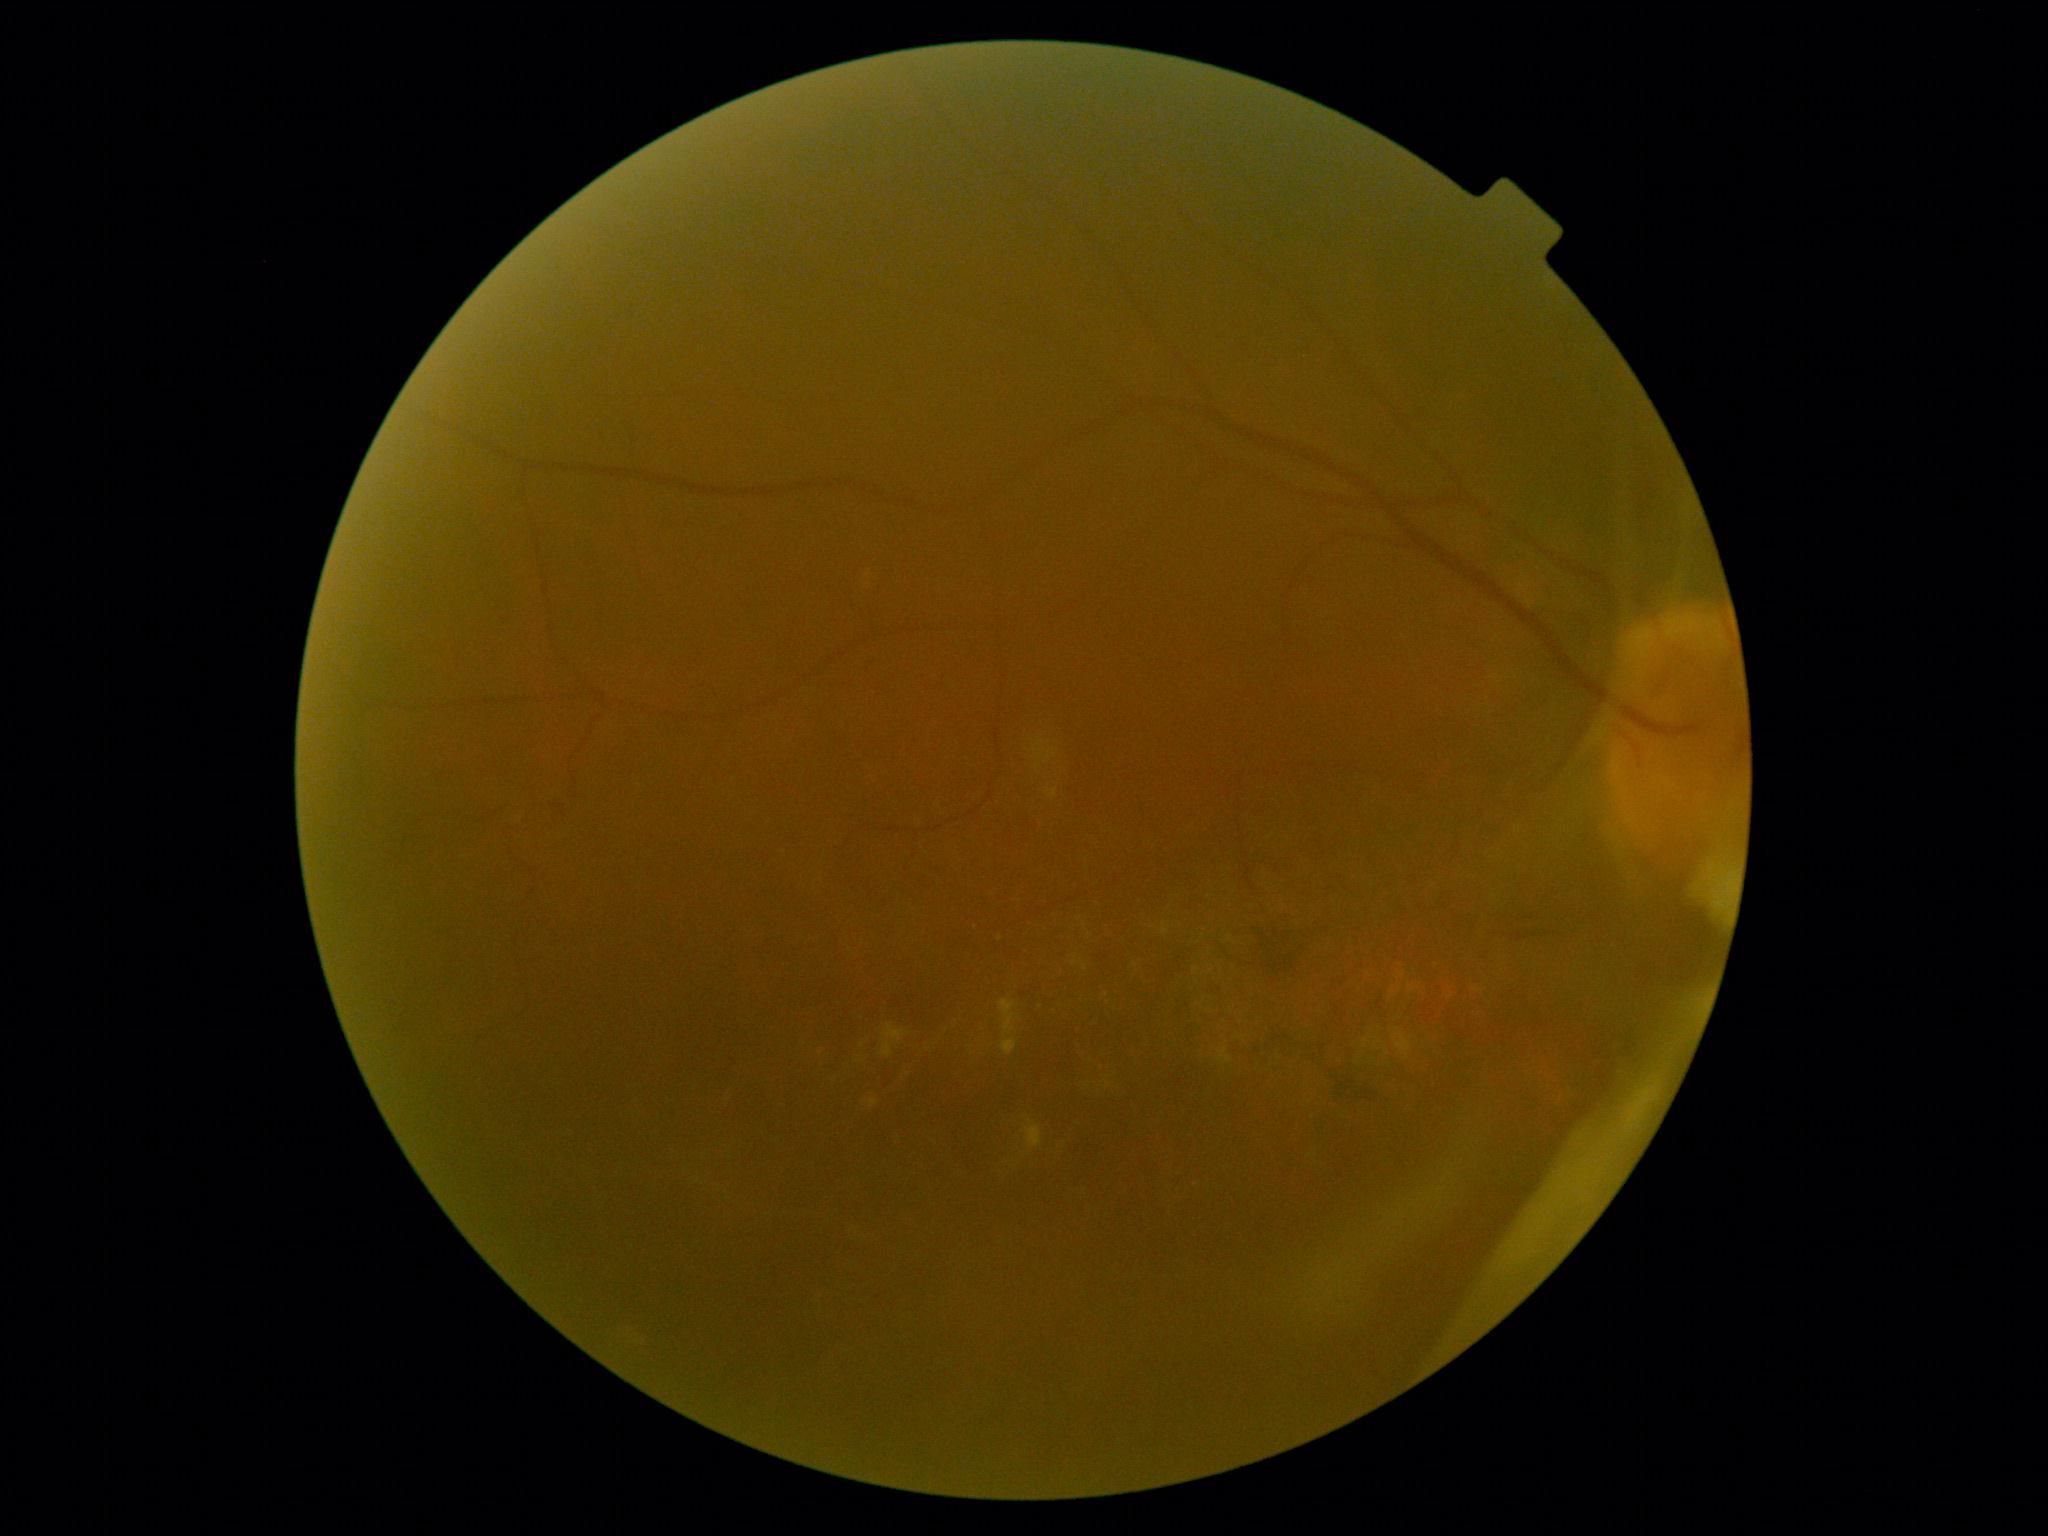 {"dr_category": "proliferative diabetic retinopathy", "dr_grade": "grade 4 (PDR)"}